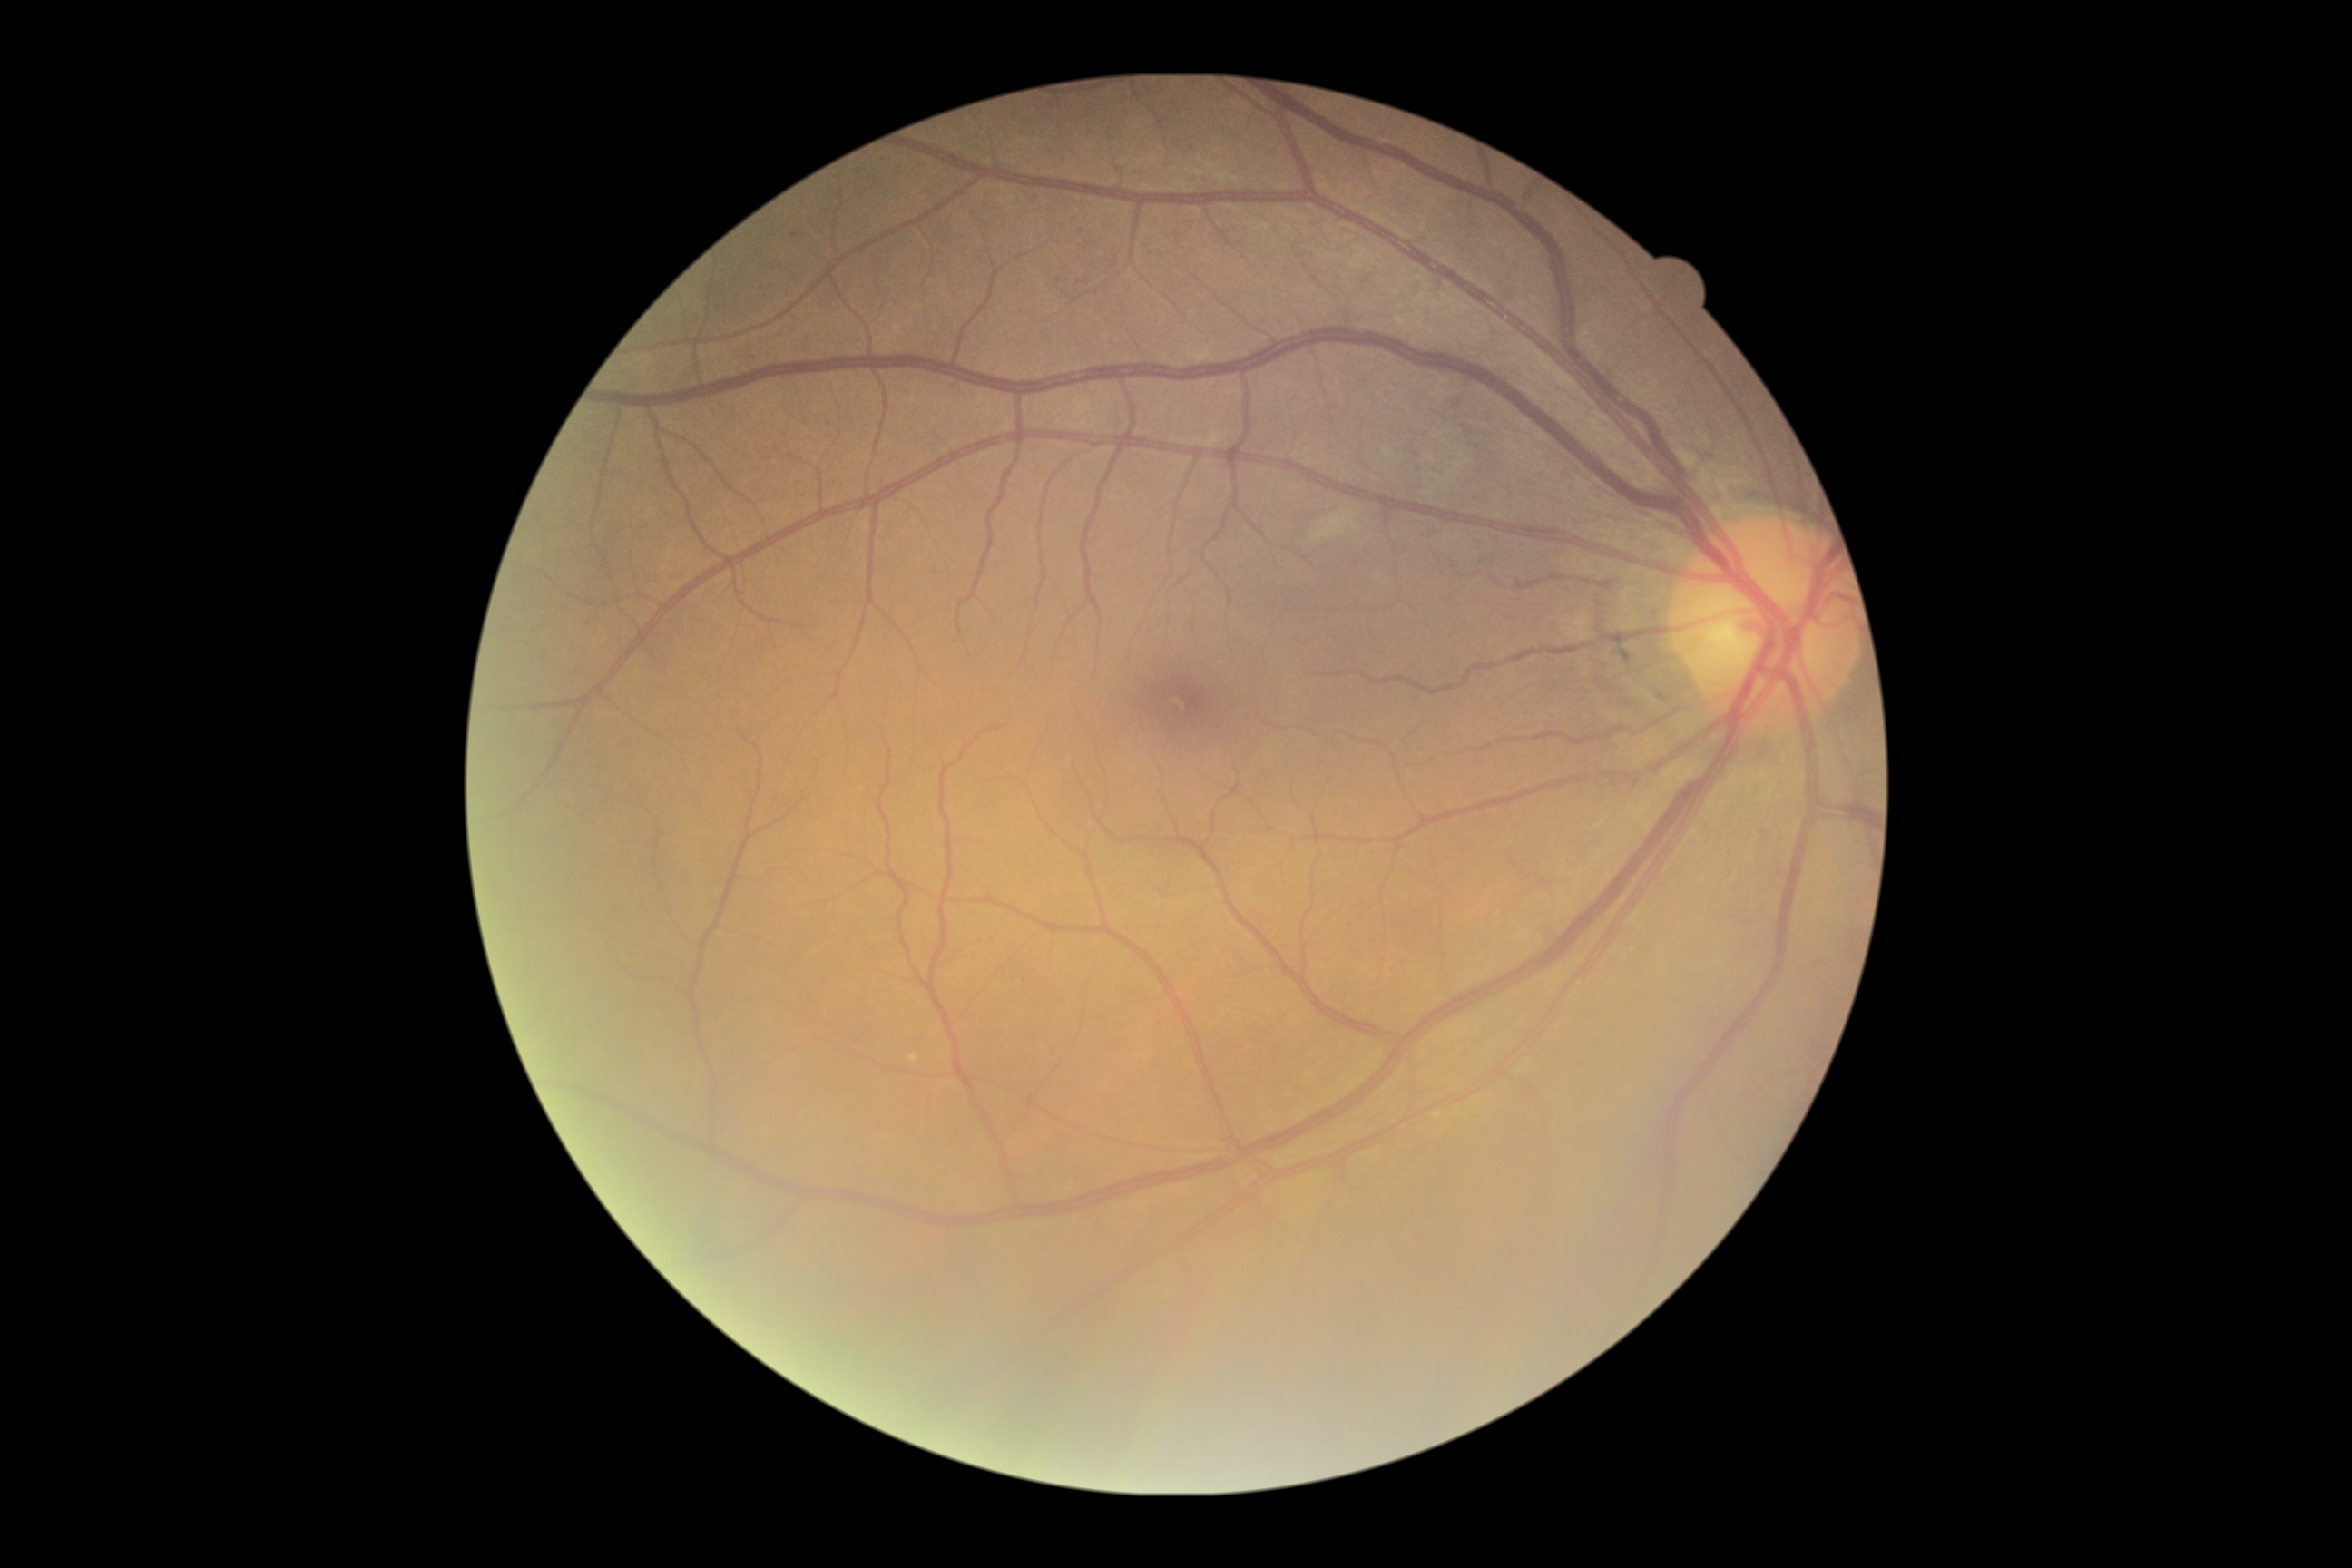
Diabetic retinopathy (DR): grade 2 (moderate NPDR) — more than just microaneurysms but less than severe NPDR.